Wide-field fundus photograph of an infant. 640x480.
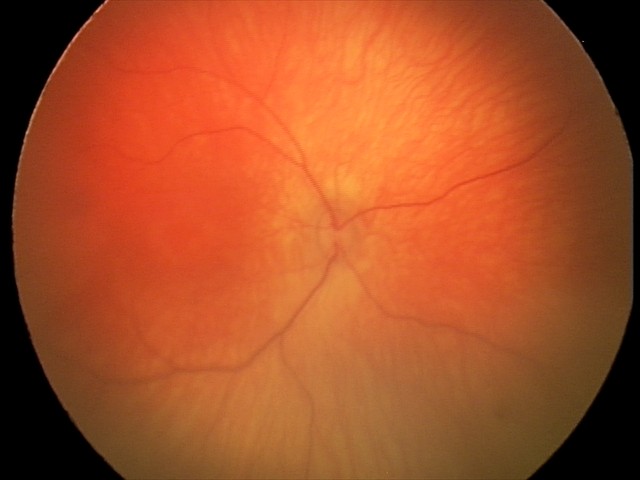

Q: What was the screening finding?
A: physiological appearance with no retinal pathology